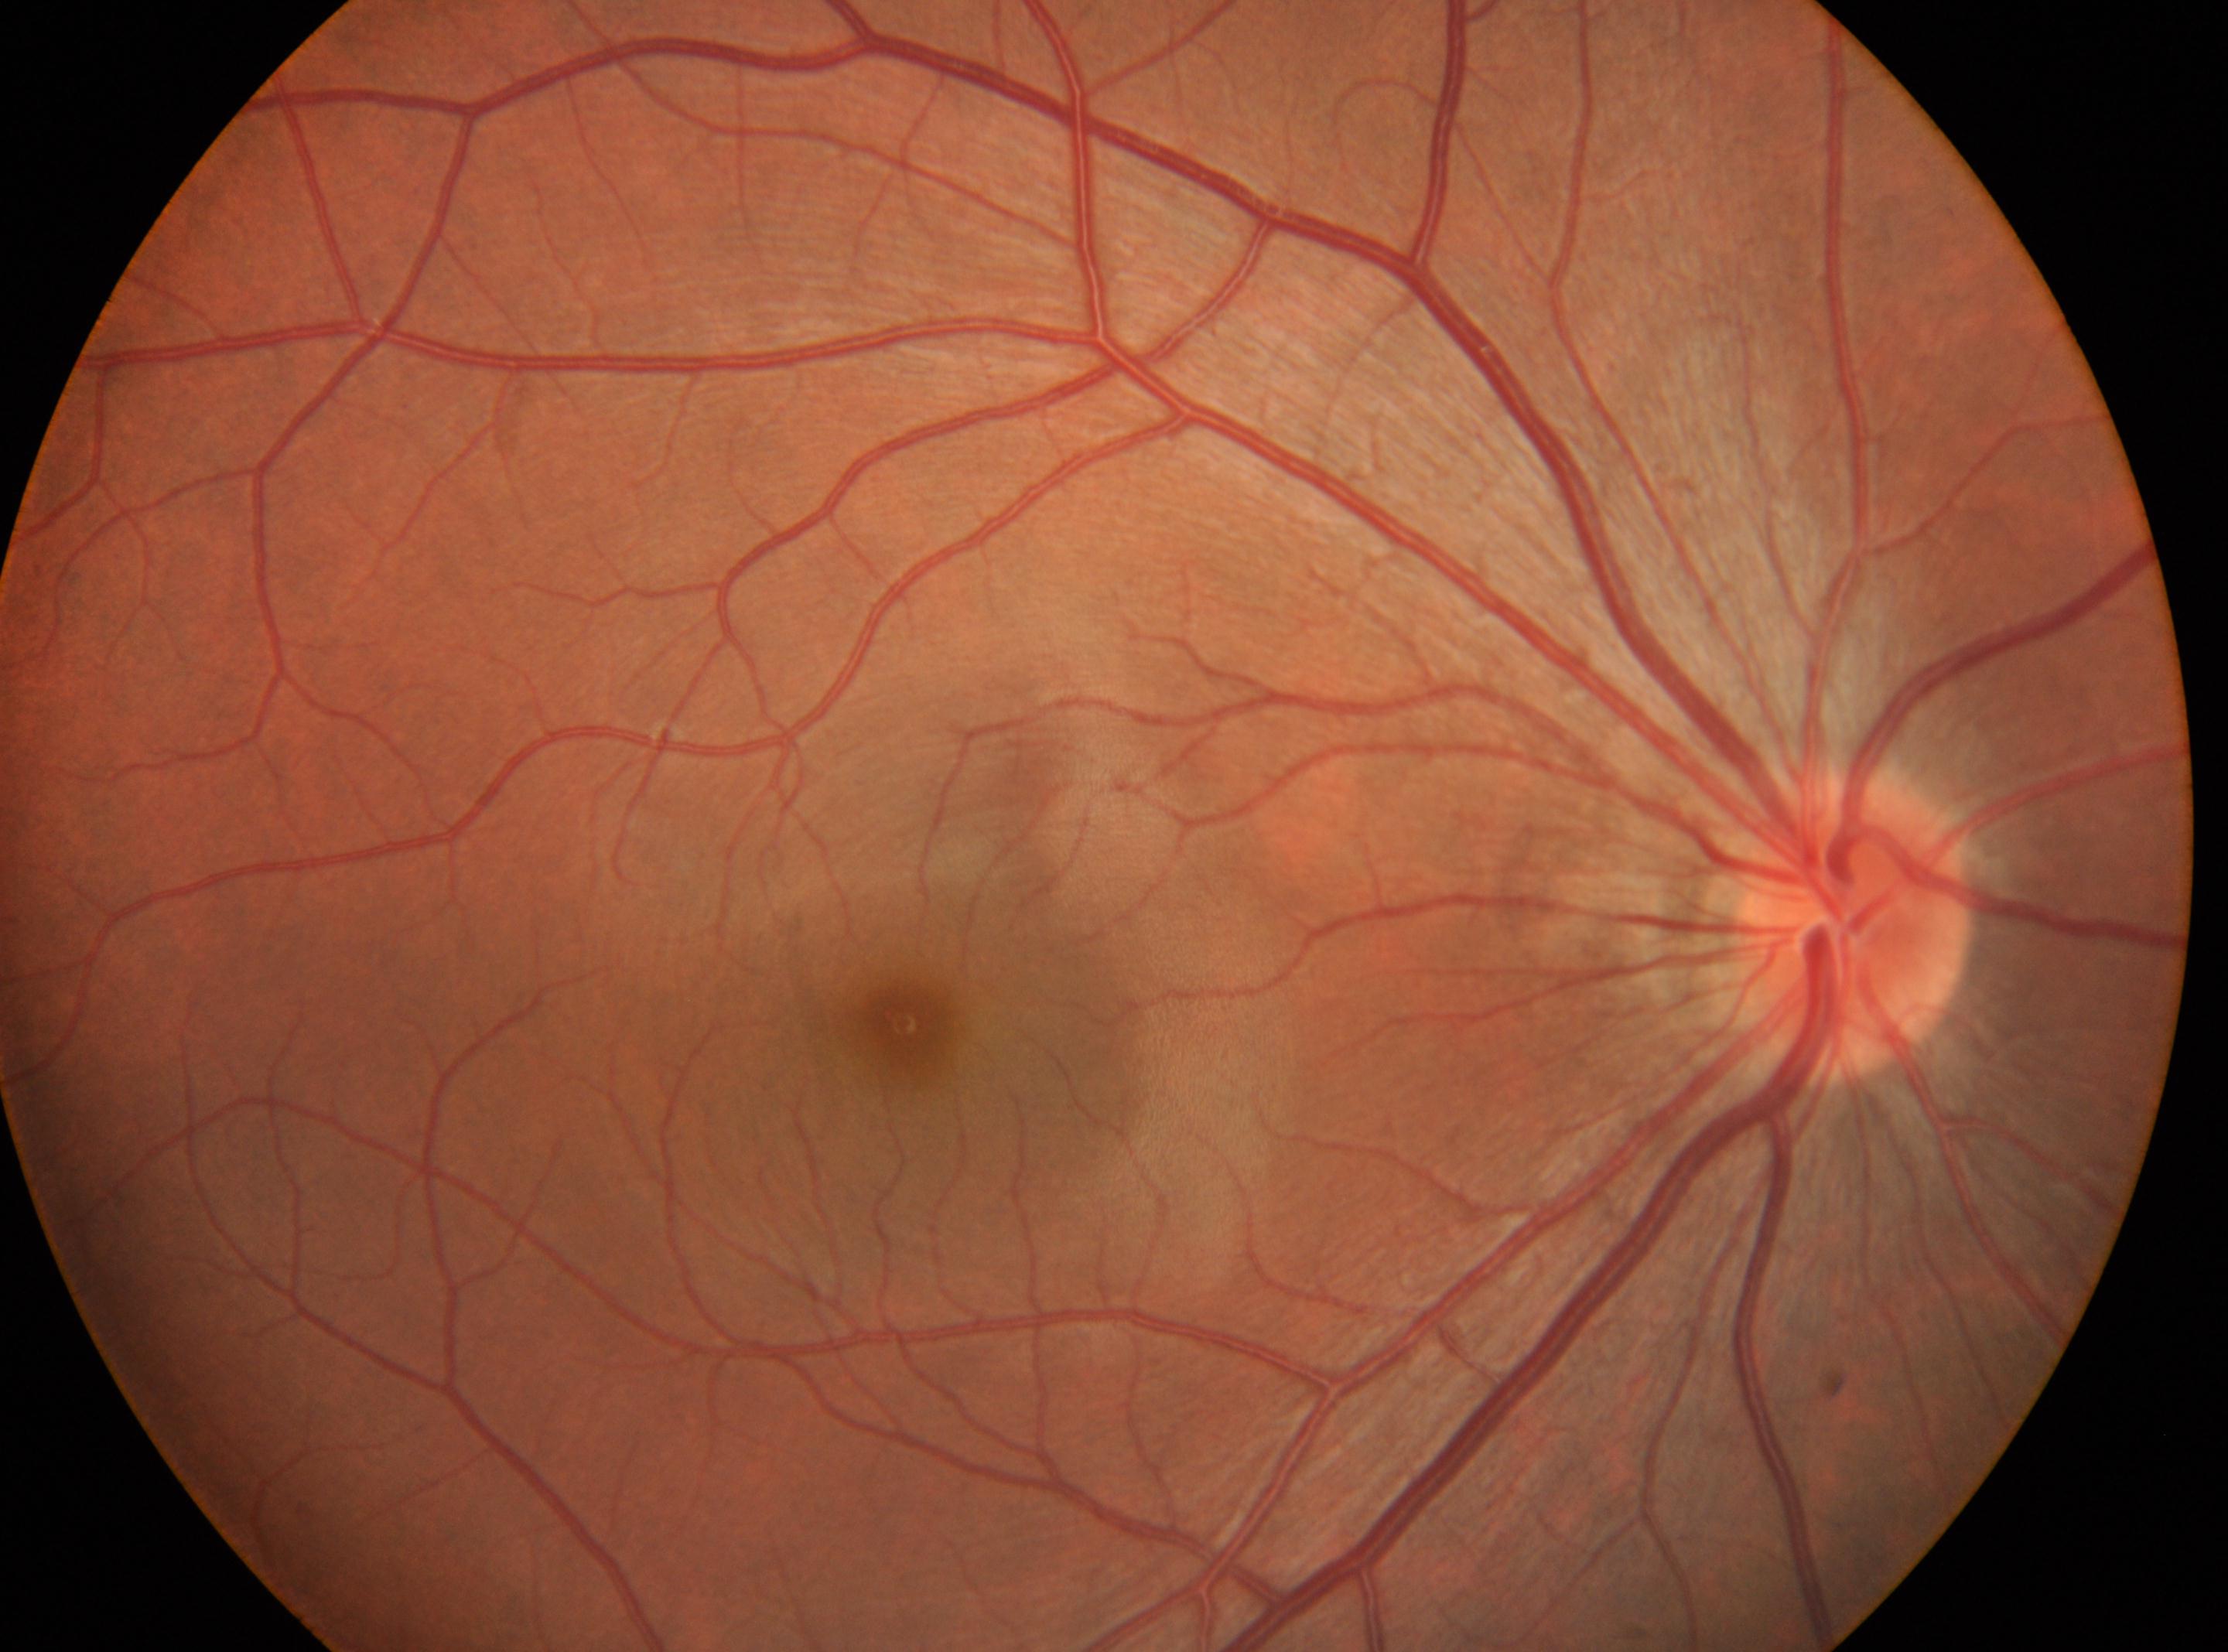
The fovea center is at 902px, 1022px.
The optic disk is at 1852px, 931px.
The image shows the right eye.
Diabetic retinopathy grade: 0 (no apparent retinopathy).